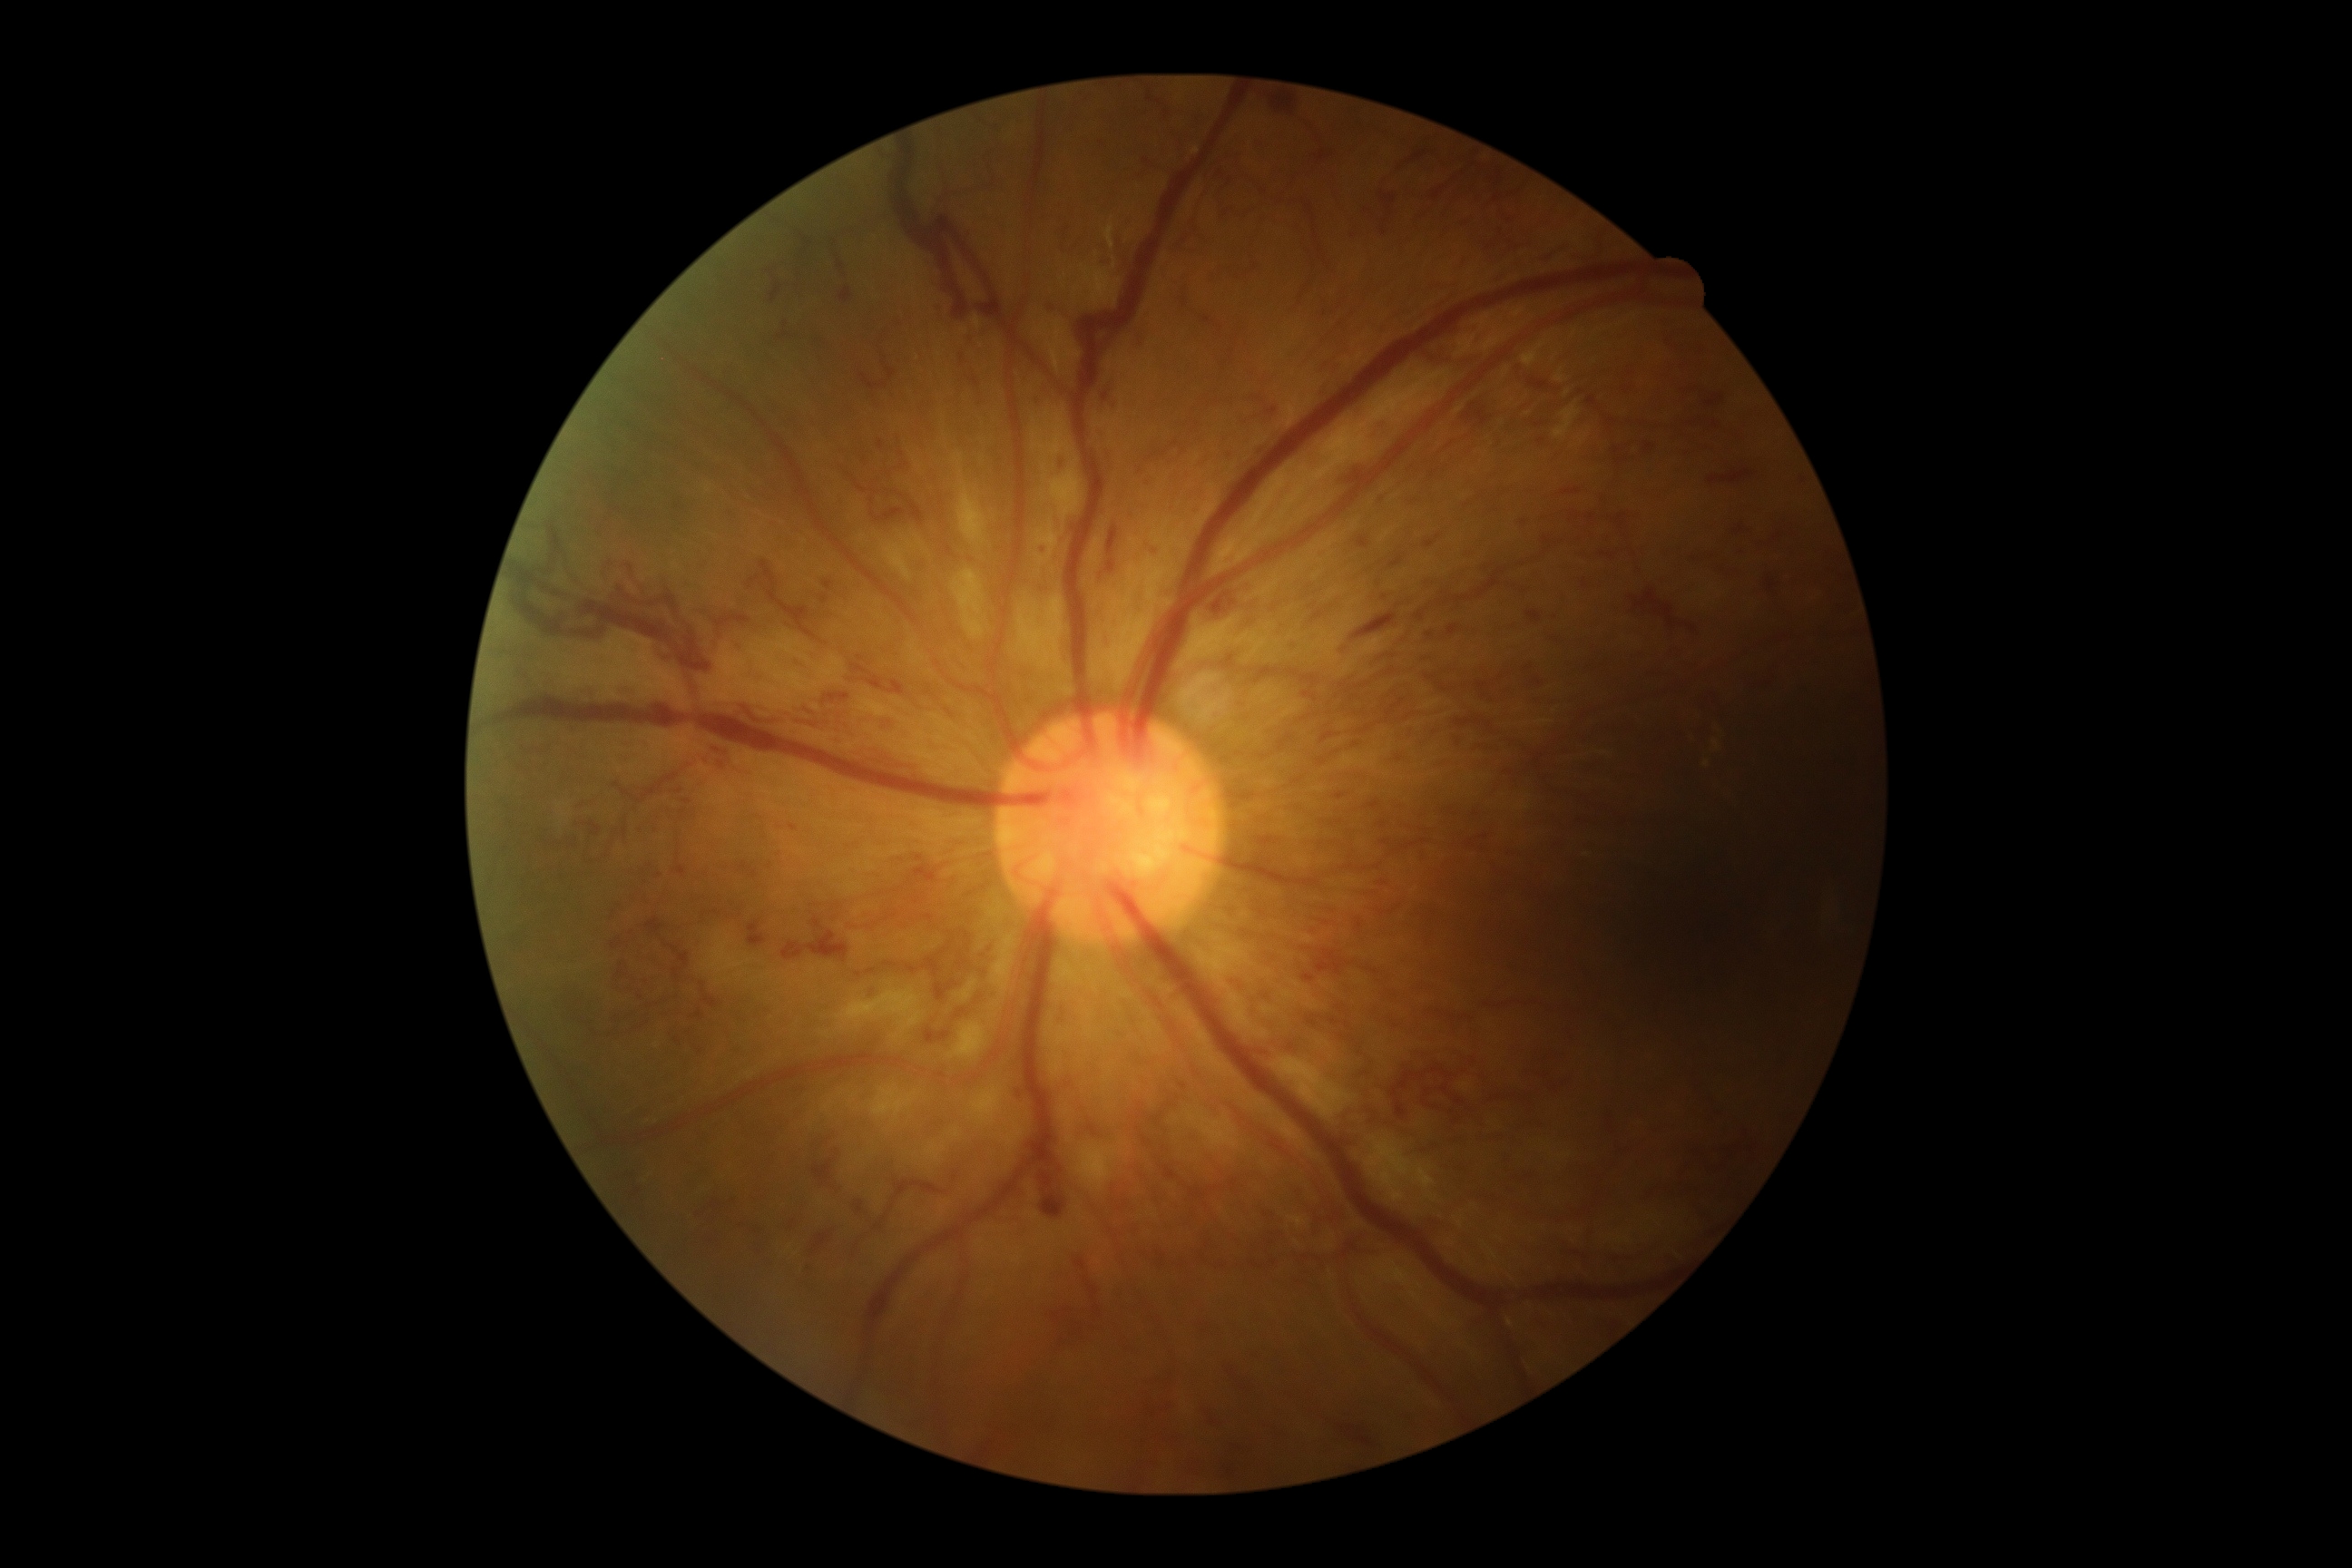
Retinopathy is 3/4 — more than 20 intraretinal hemorrhages in each of 4 quadrants, definite venous beading in 2 or more quadrants, or prominent intraretinal microvascular abnormalities in 1 or more quadrants, with no signs of proliferative retinopathy.